45-degree field of view:
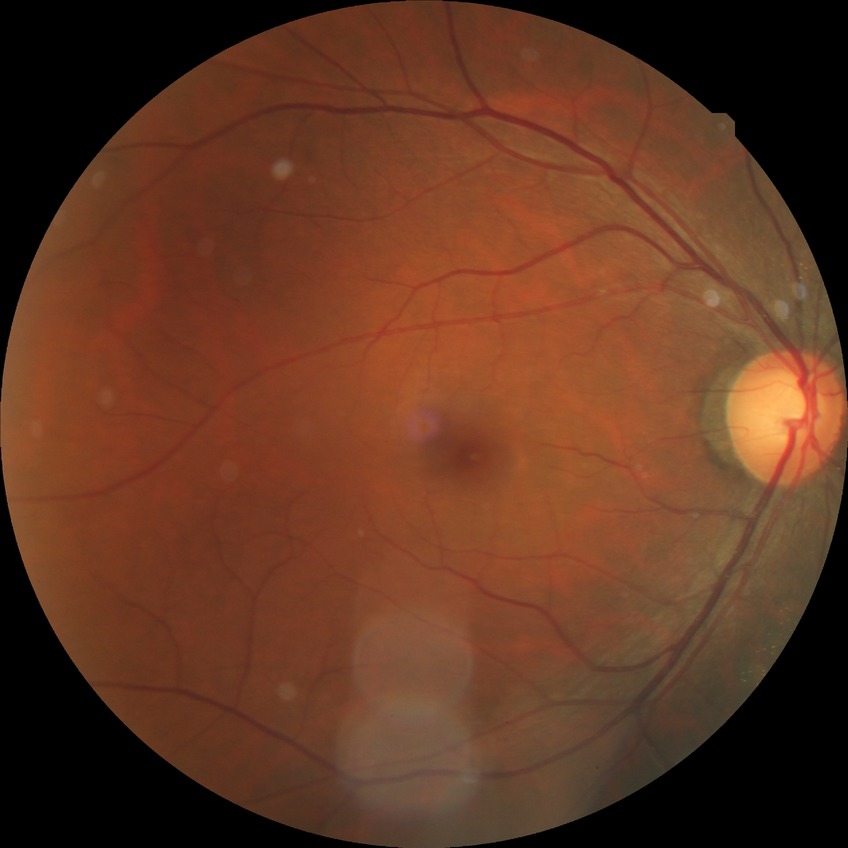
Annotations:
• modified Davis classification: no diabetic retinopathy